CFP:
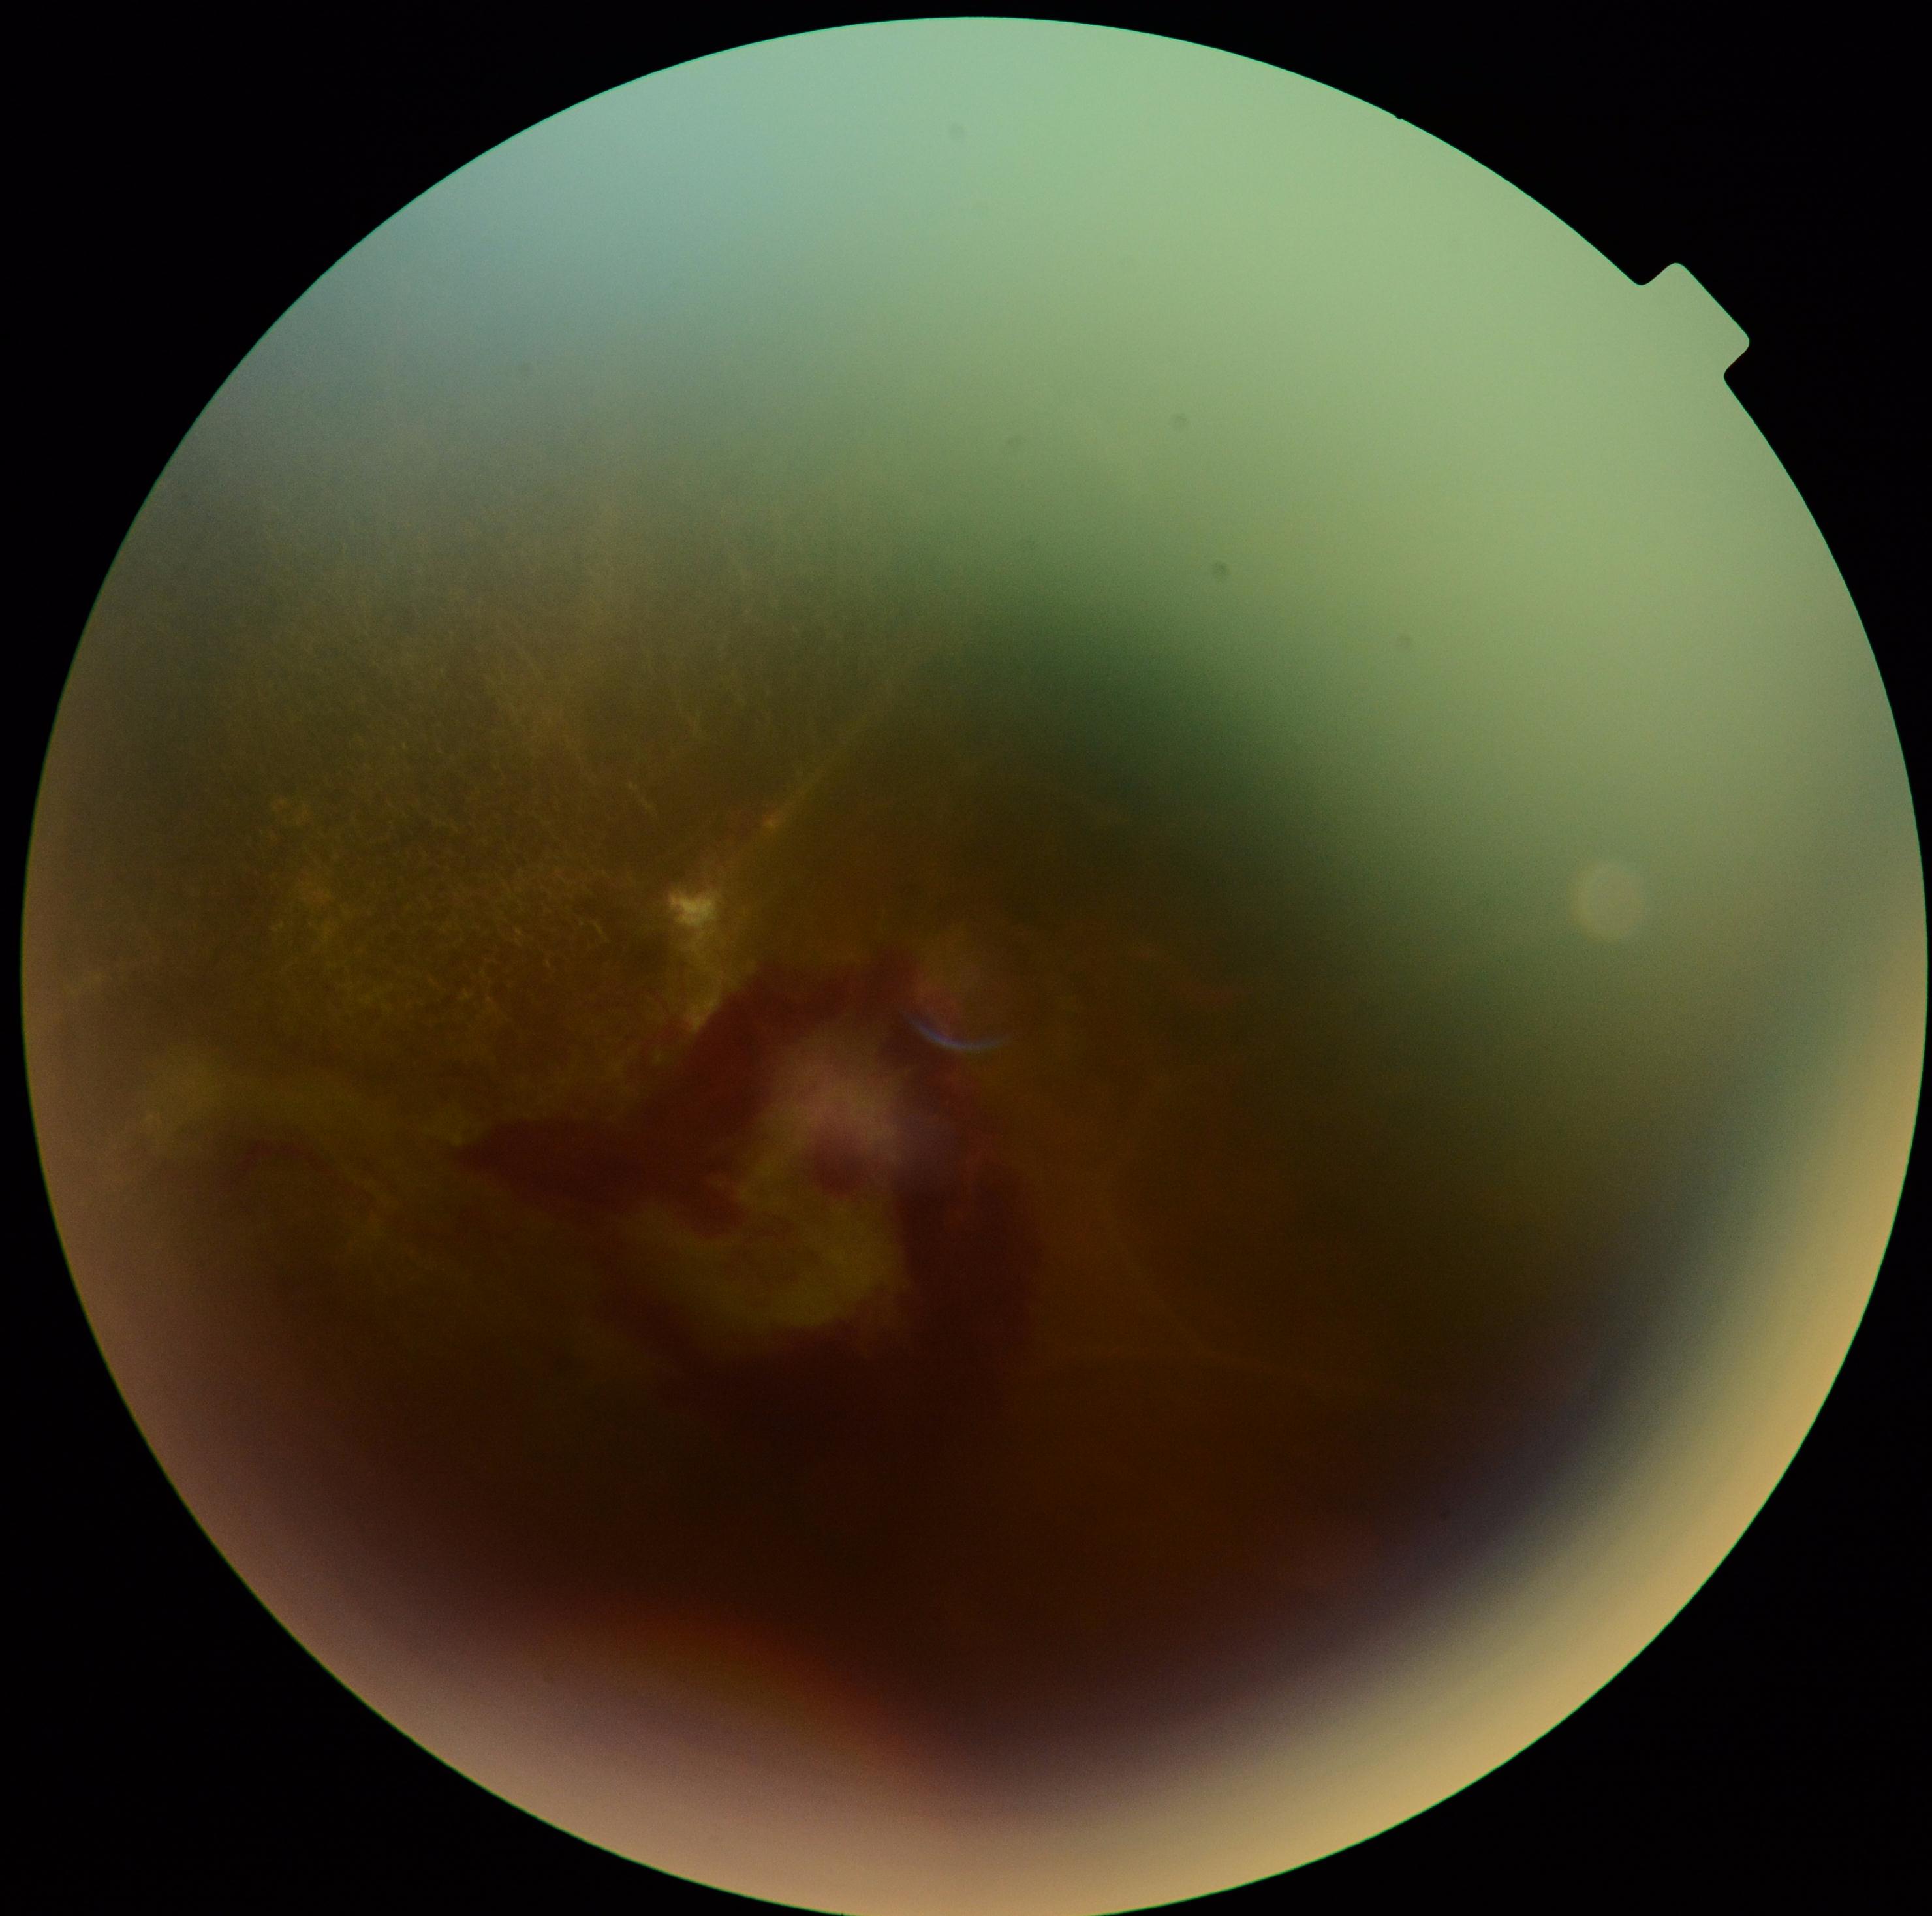 {
  "dr_grade": "4/4"
}